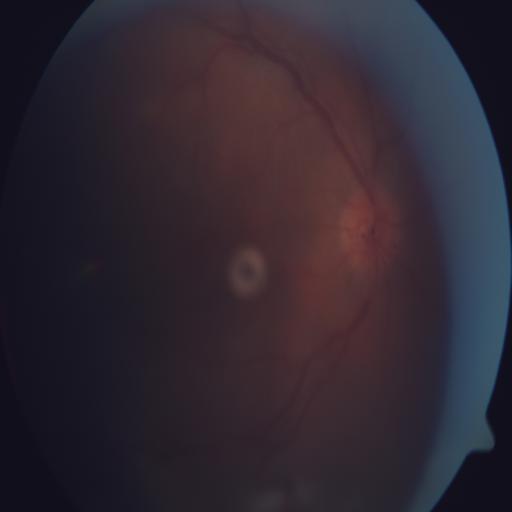
Diagnoses: optociliary shunt.